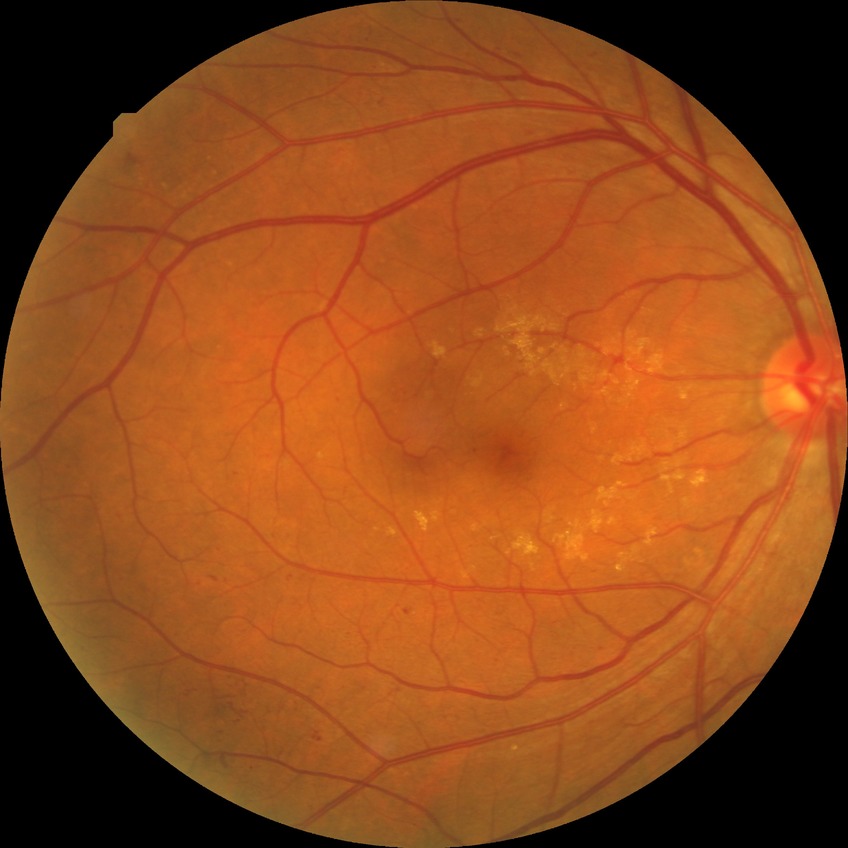 Diabetic retinopathy (DR) is simple diabetic retinopathy (SDR).